2352x1568px — 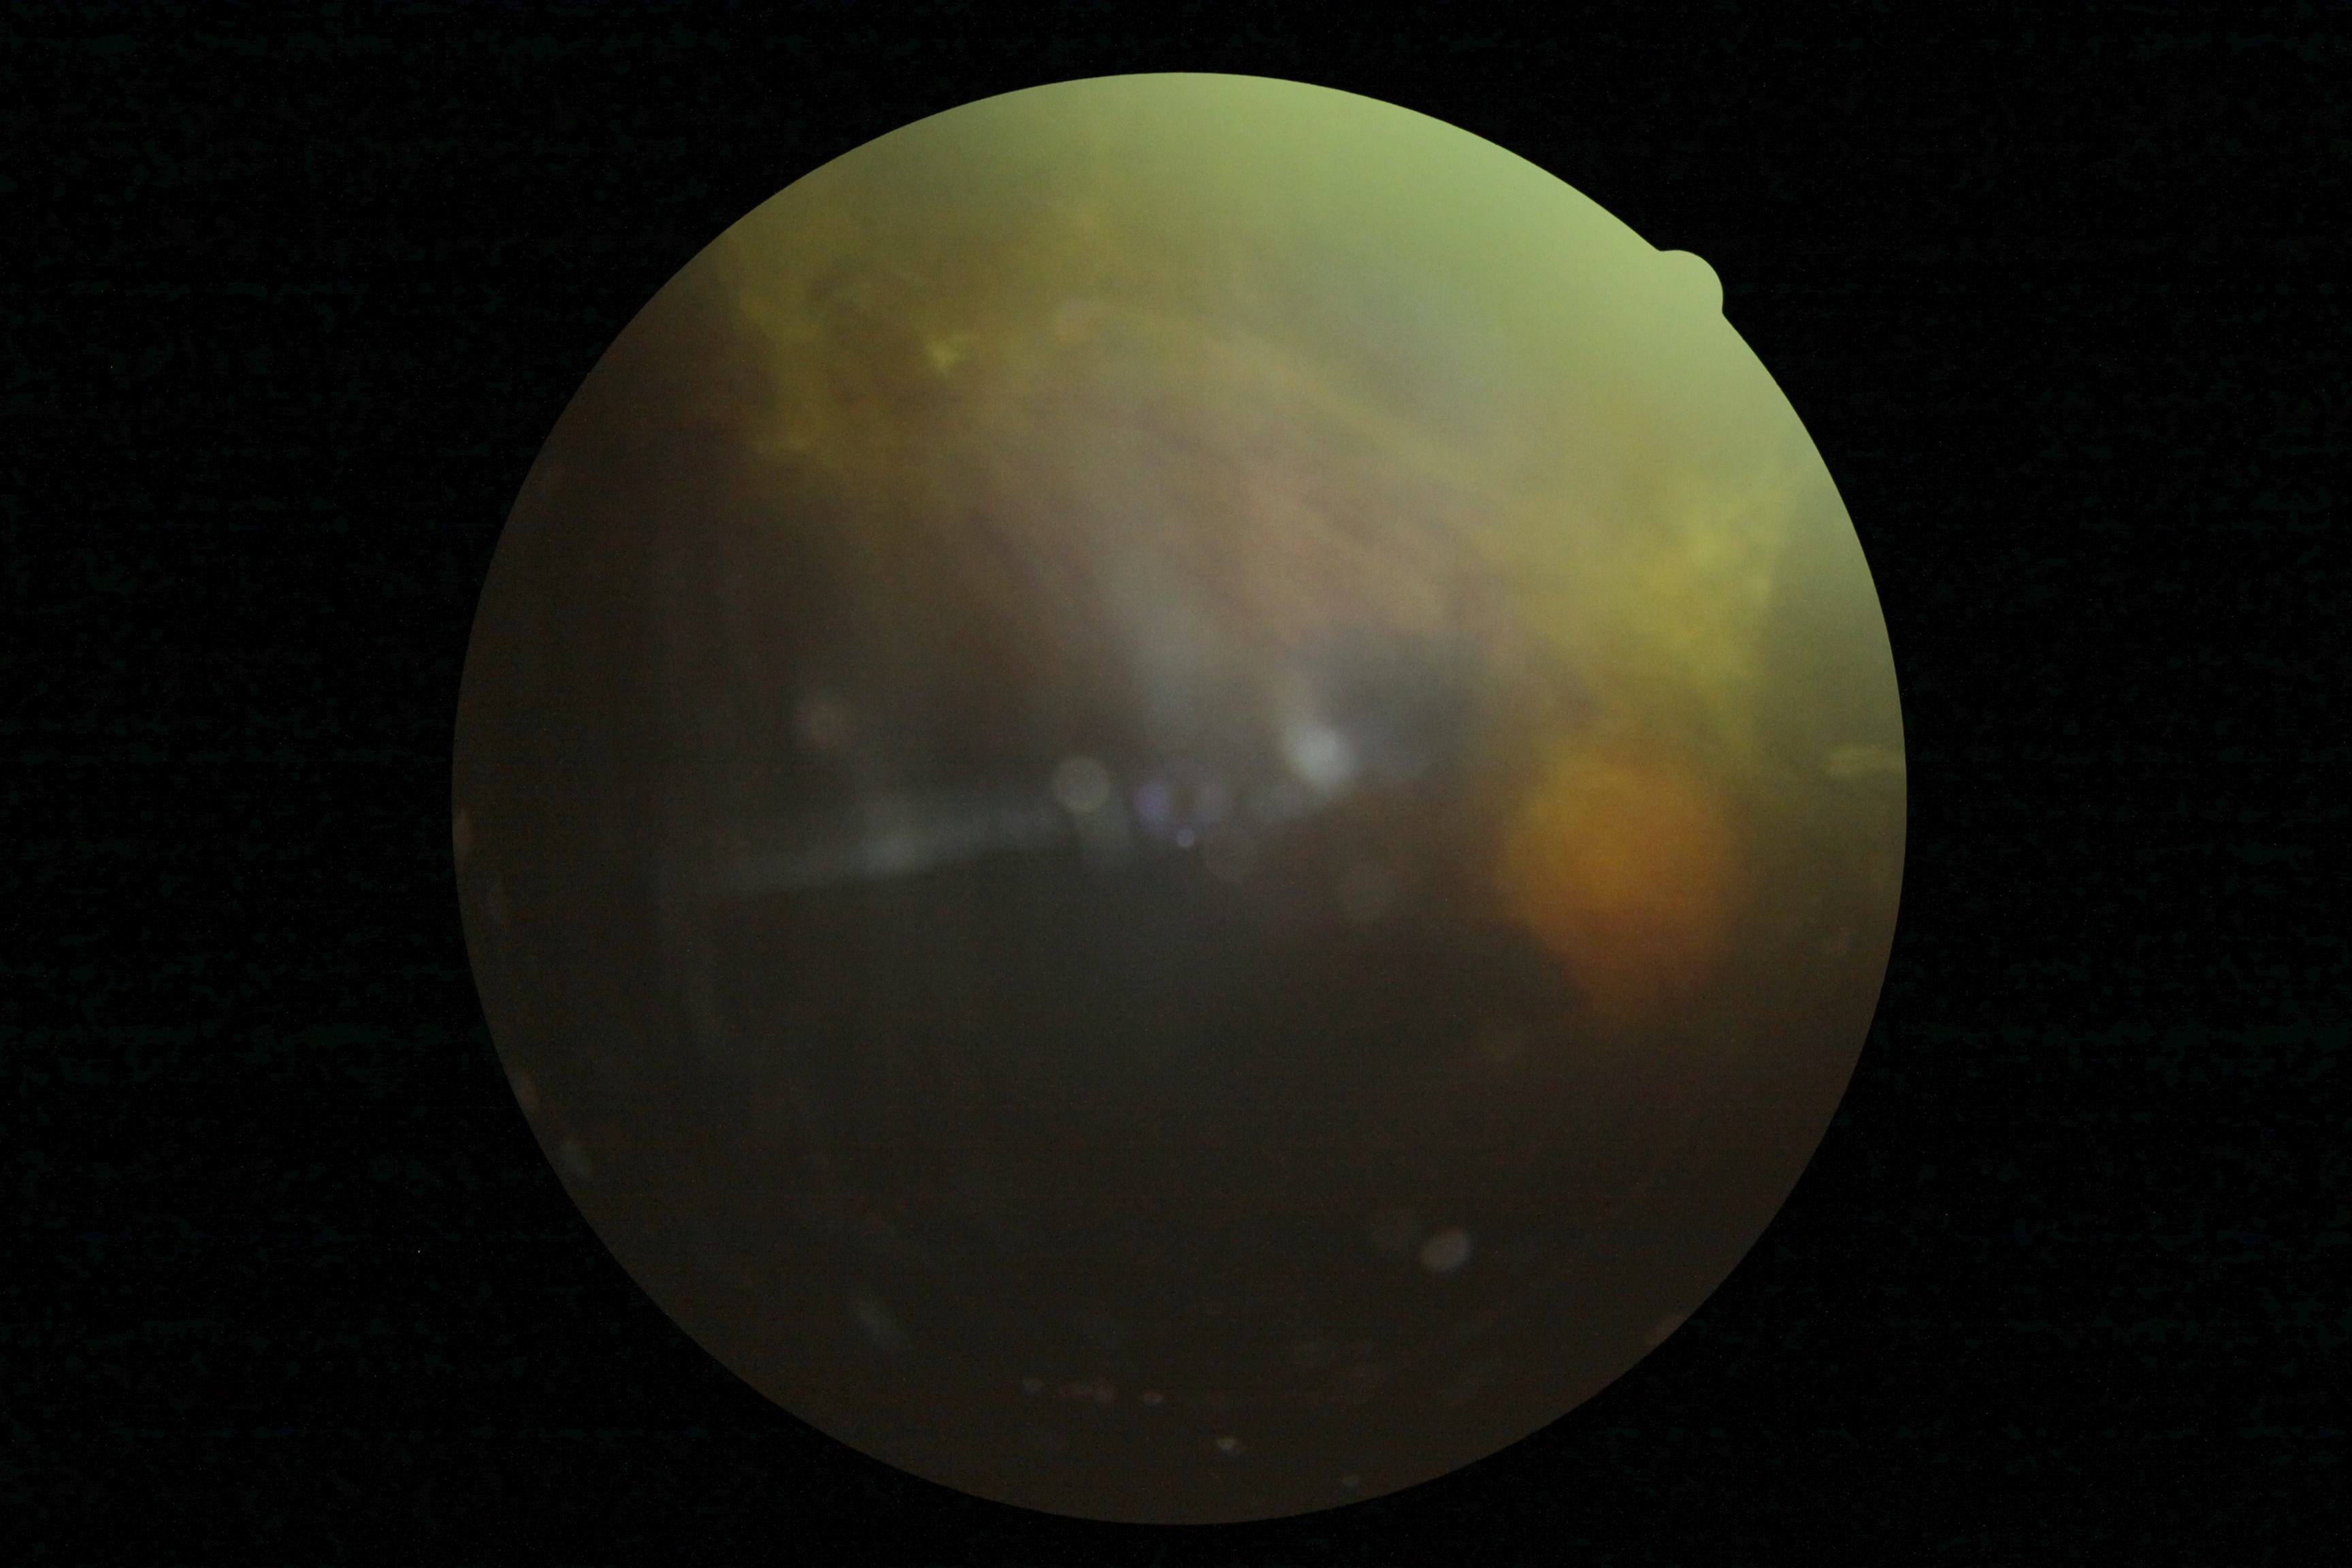

diabetic retinopathy@4.